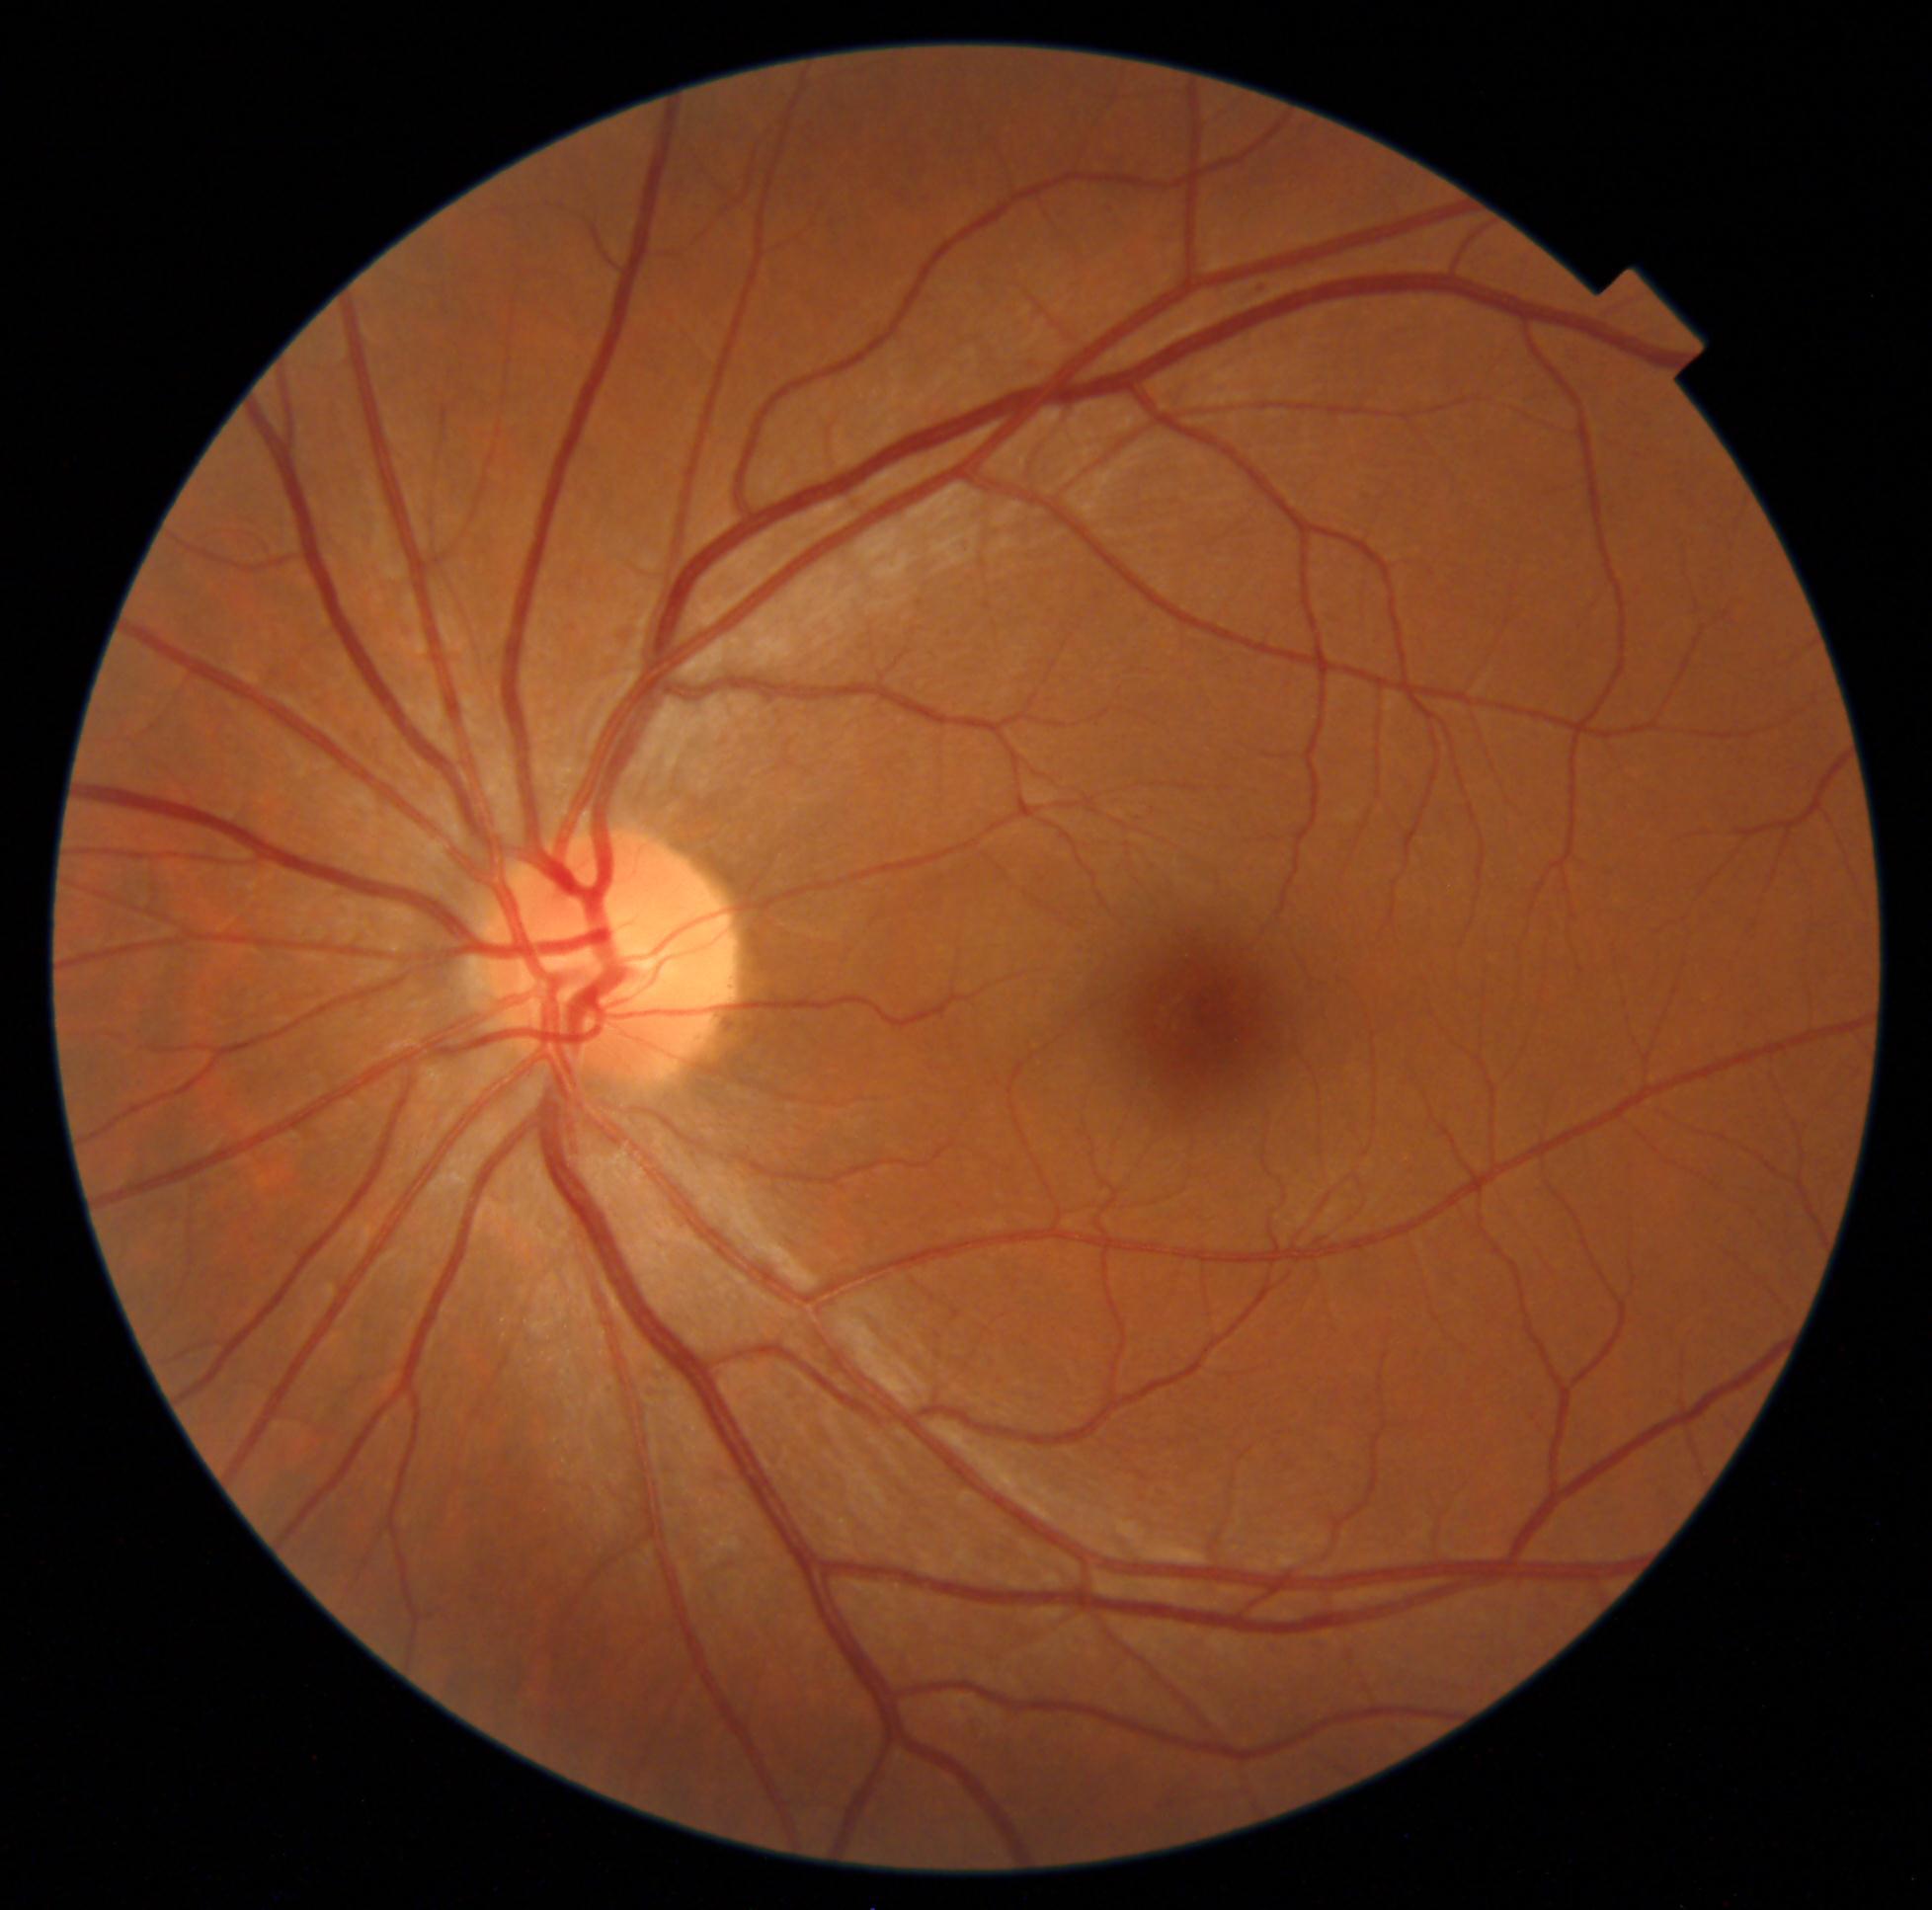 retinopathy@mild NPDR (grade 1).